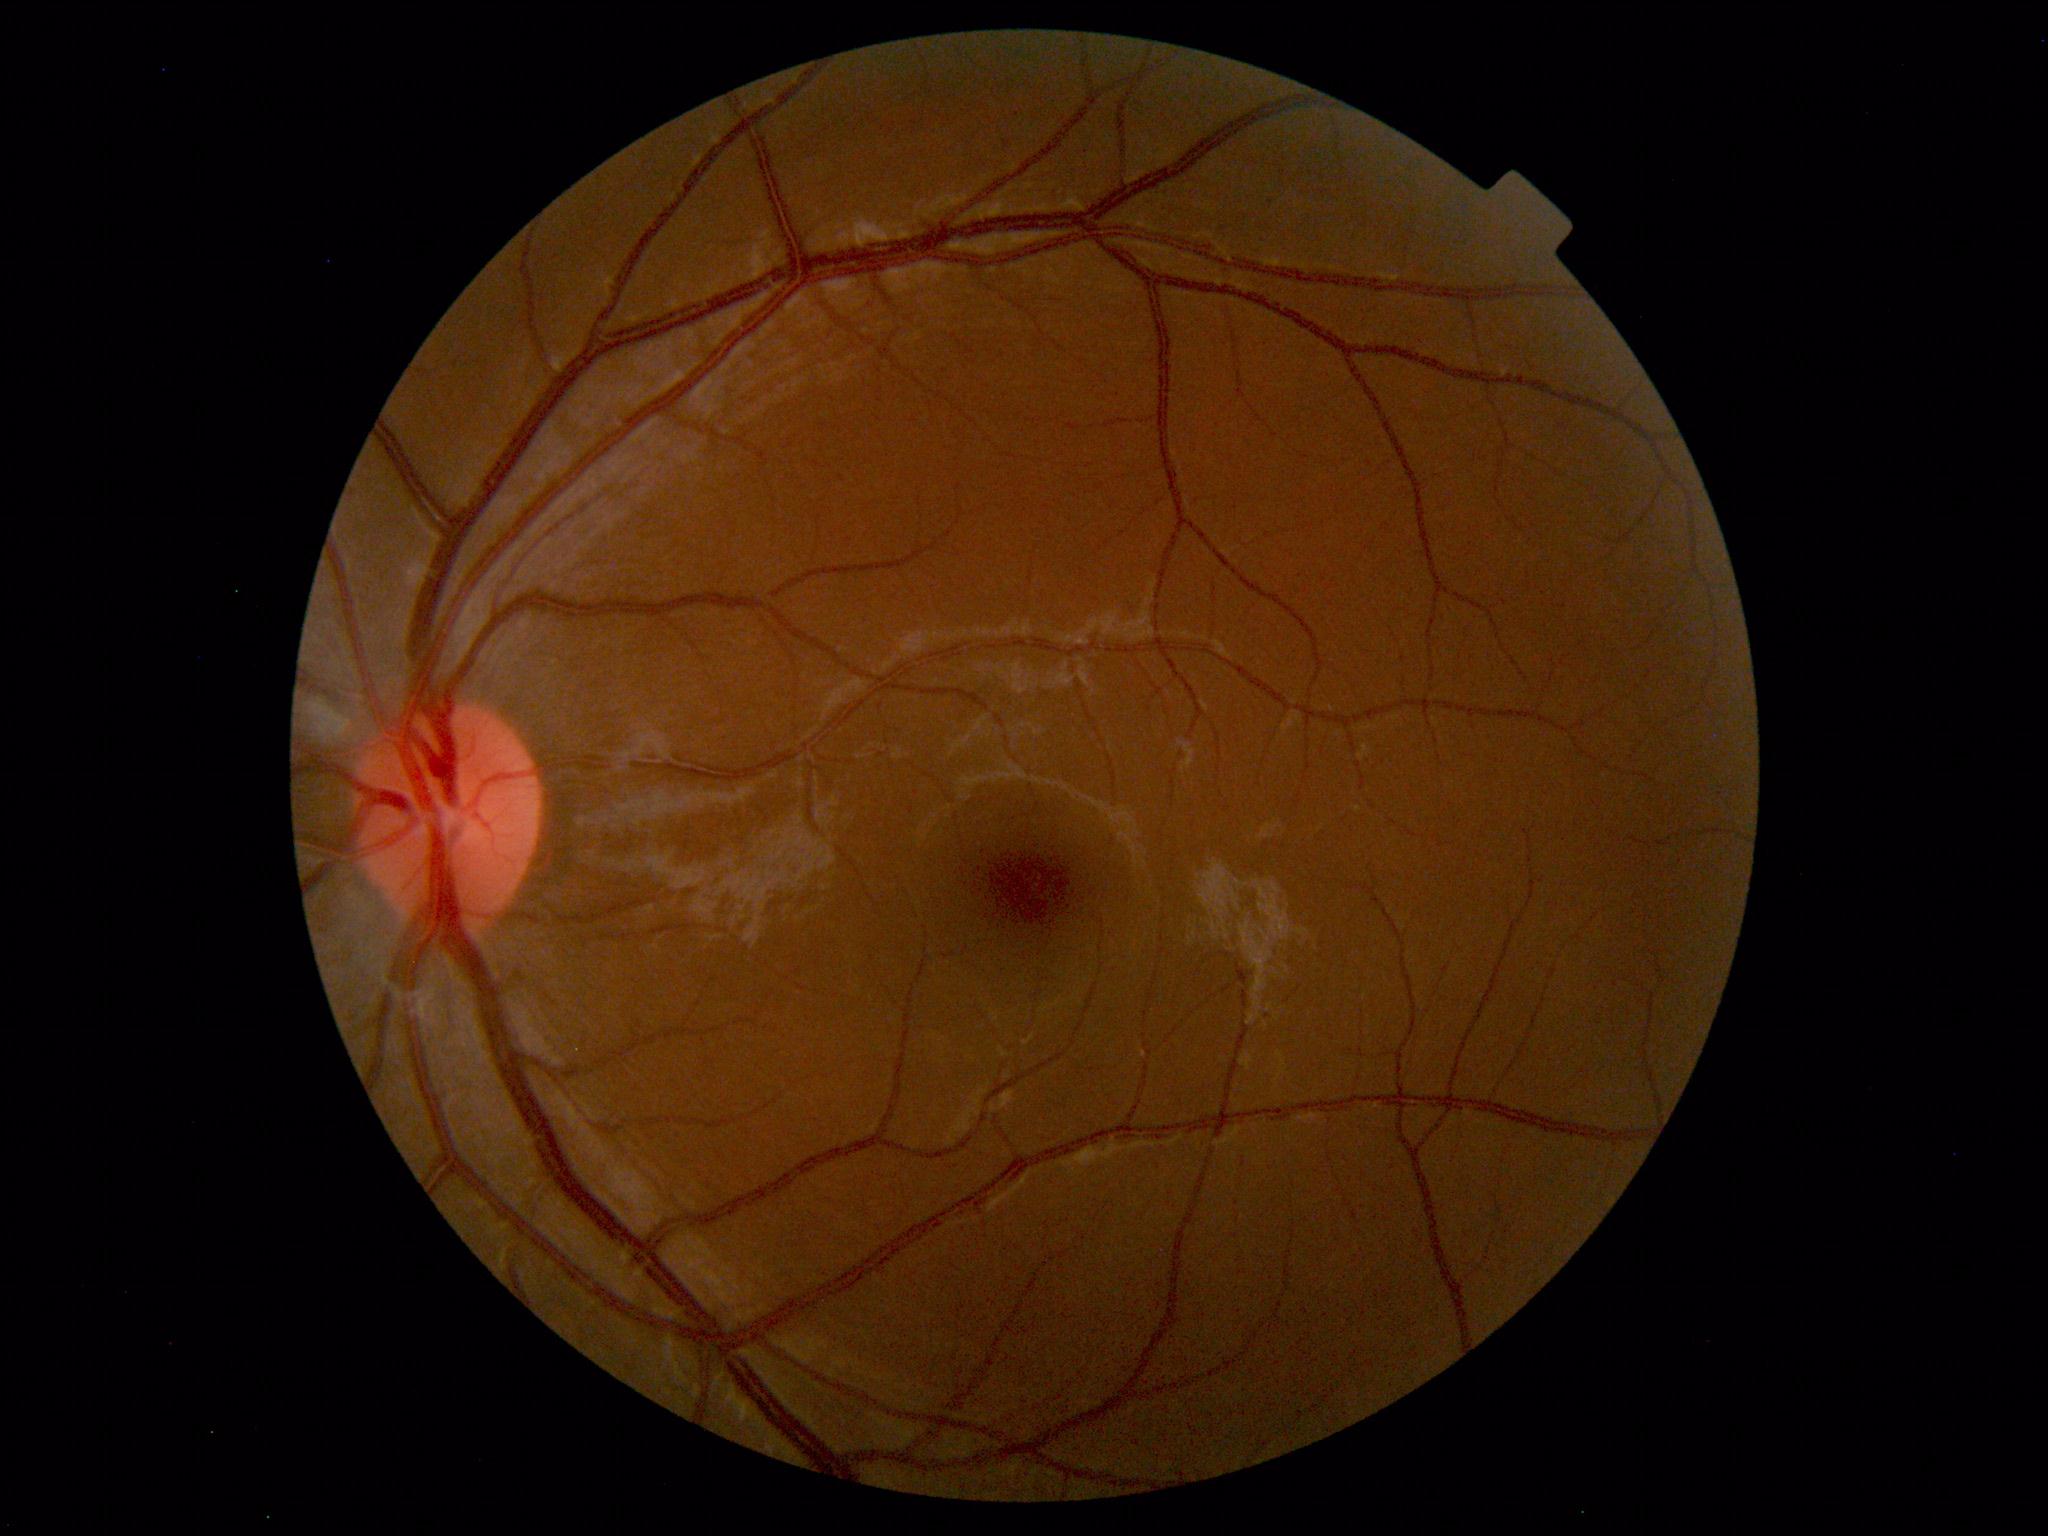

Findings: none. Normal fundus.